640x480 · wide-field fundus photograph of an infant: 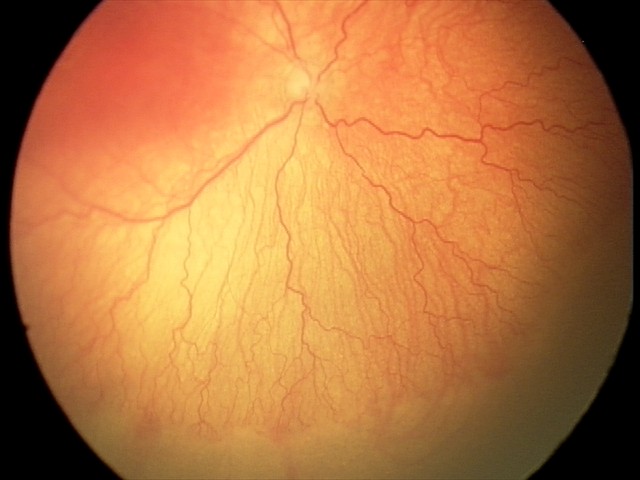 Impression = aggressive retinopathy of prematurity.